Nonmydriatic fundus photograph · Davis DR grading · CFP · 848x848 · 45° FOV · NIDEK AFC-230 fundus camera — 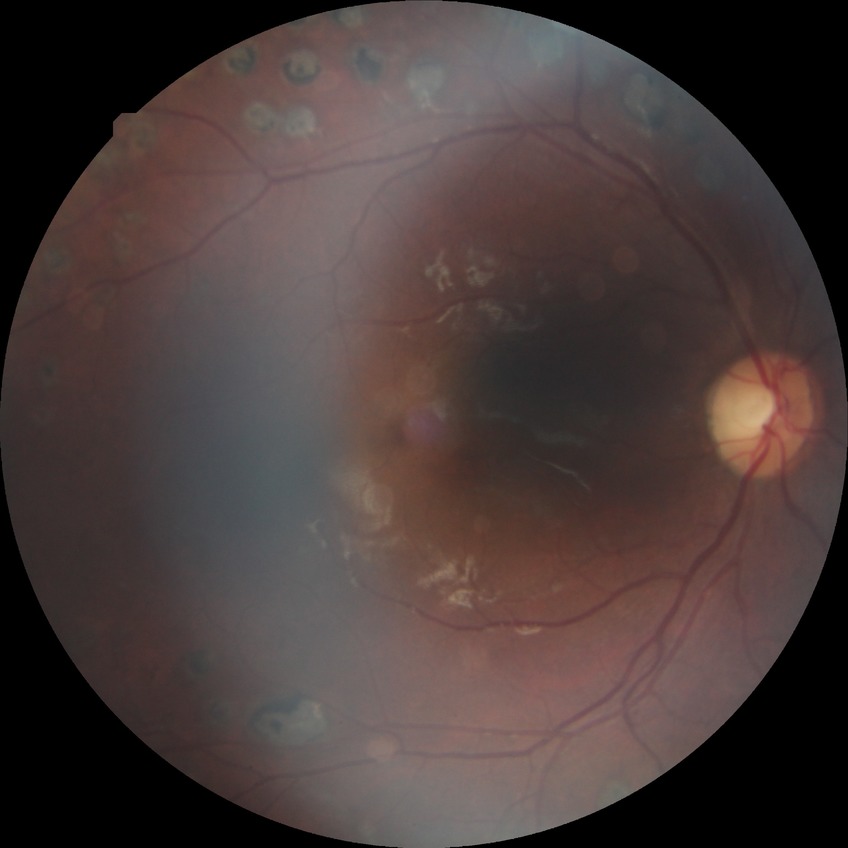 {"davis_grade": "PDR (proliferative diabetic retinopathy)"}